Wide-field fundus photograph from neonatal ROP screening; acquired on the Clarity RetCam 3; 640 x 480 pixels — 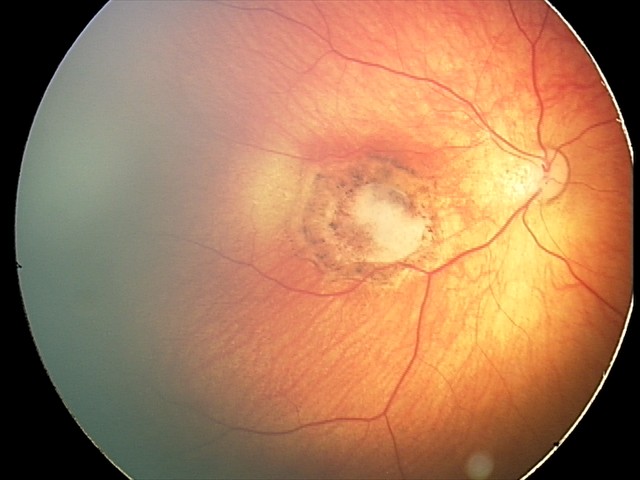

From an examination with diagnosis of toxoplasmosis chorioretinitis.